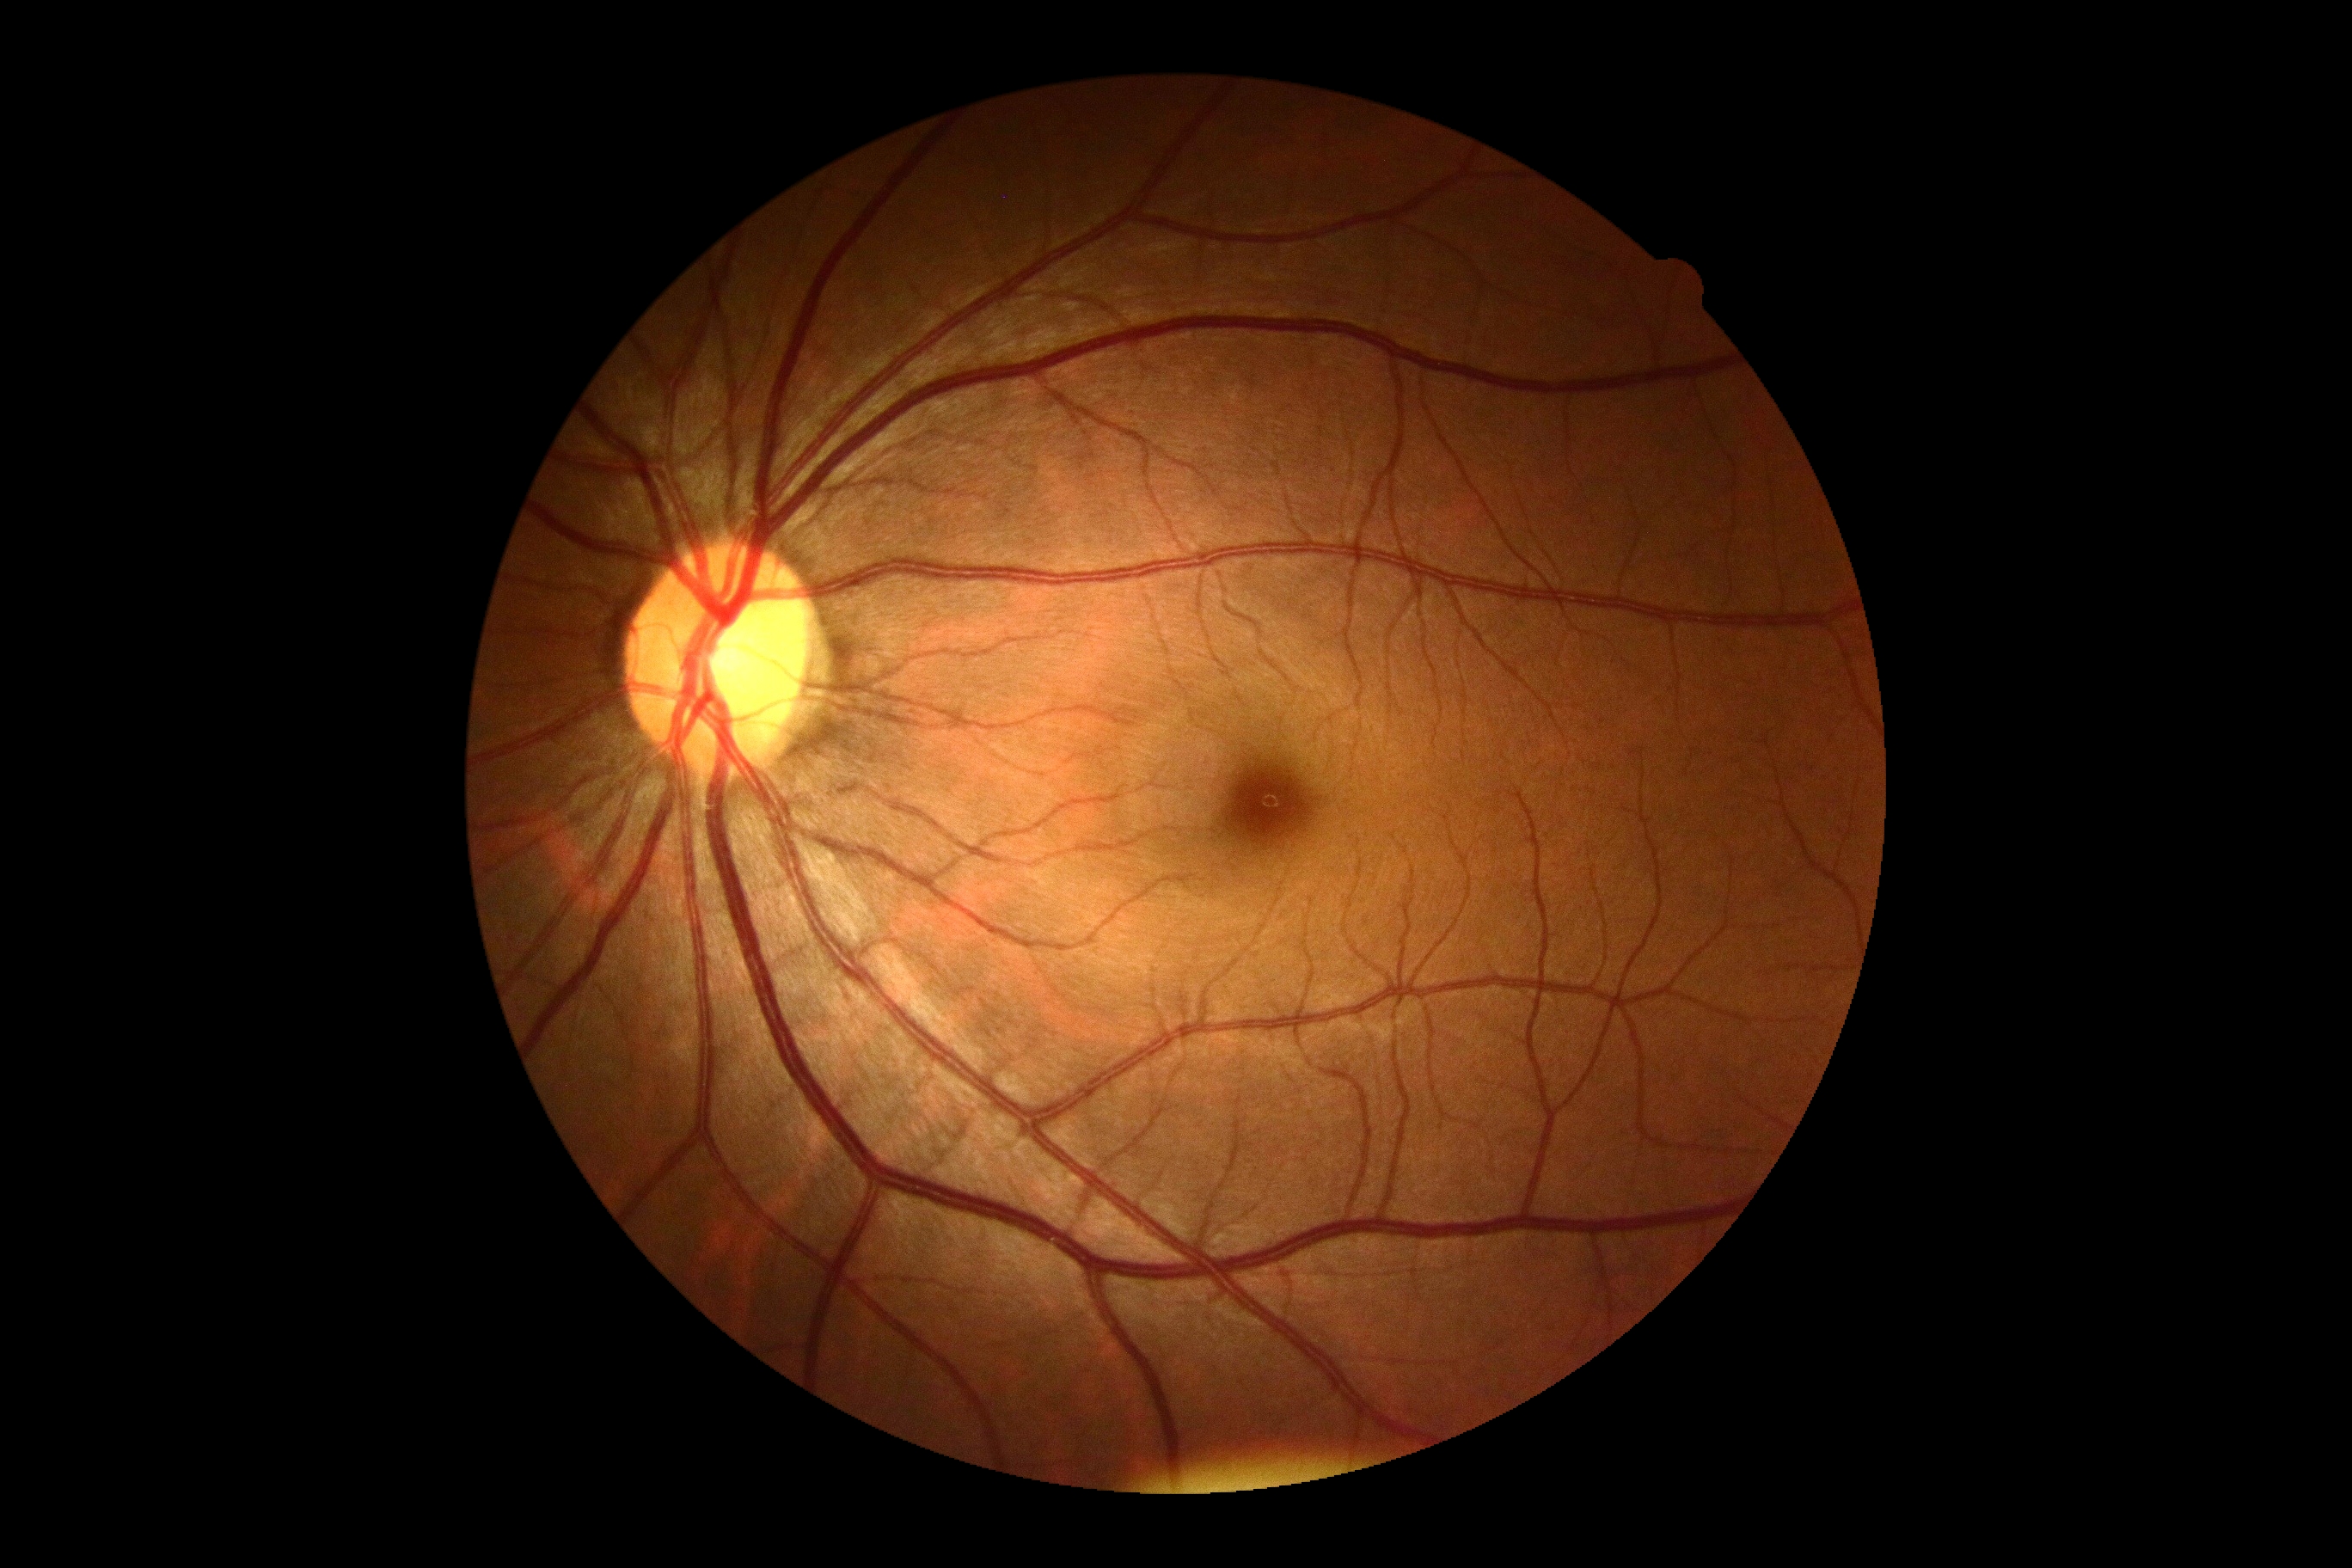
DR=grade 0 (no apparent retinopathy) — no visible signs of diabetic retinopathy.